Posterior pole photograph. 45-degree field of view. Acquired with a NIDEK AFC-230. DR severity per modified Davis staging. Nonmydriatic fundus photograph — 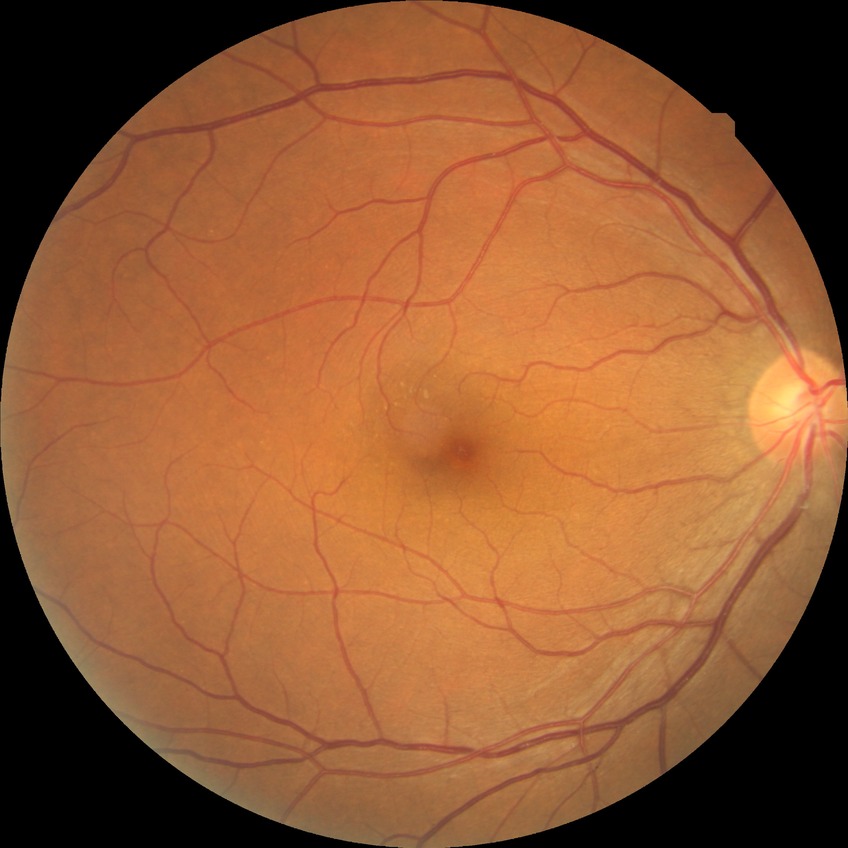

Diabetic retinopathy (DR): no diabetic retinopathy (NDR).